Topcon TRC-NW400. Gender: F
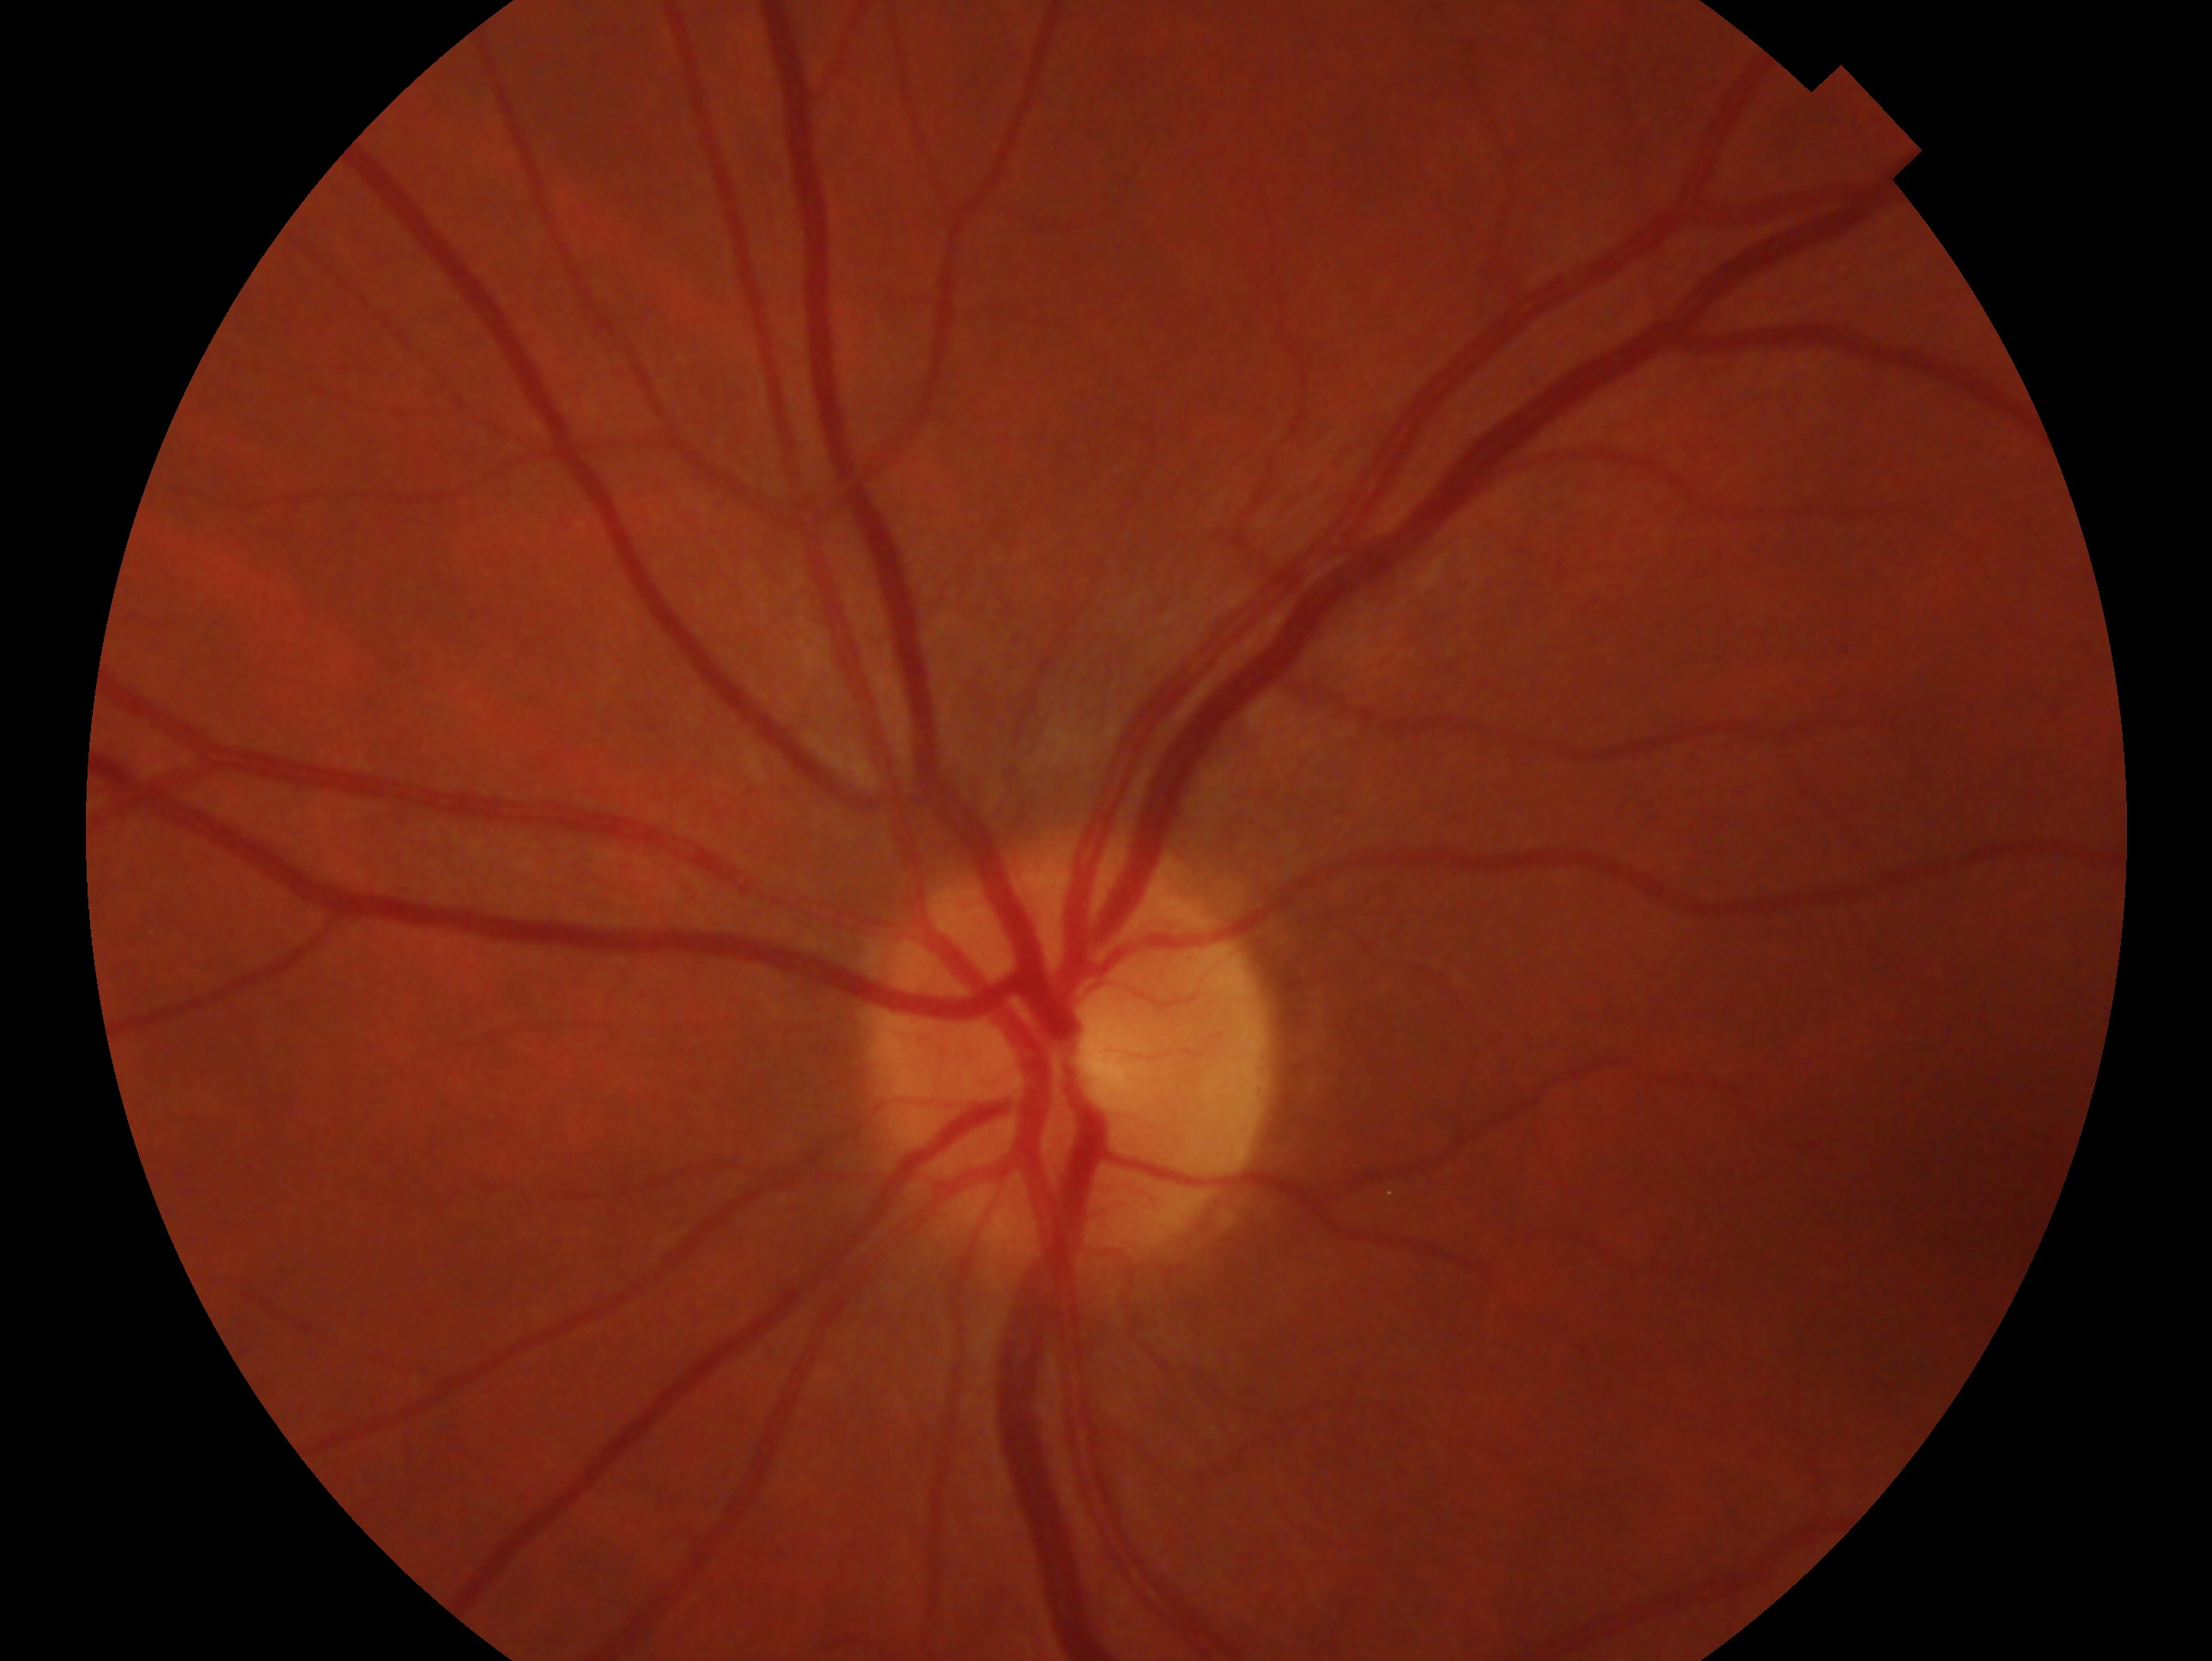
Assessment: negative for glaucoma. Eye: oculus sinister.